2212 x 1659 pixels · FOV: 45 degrees:
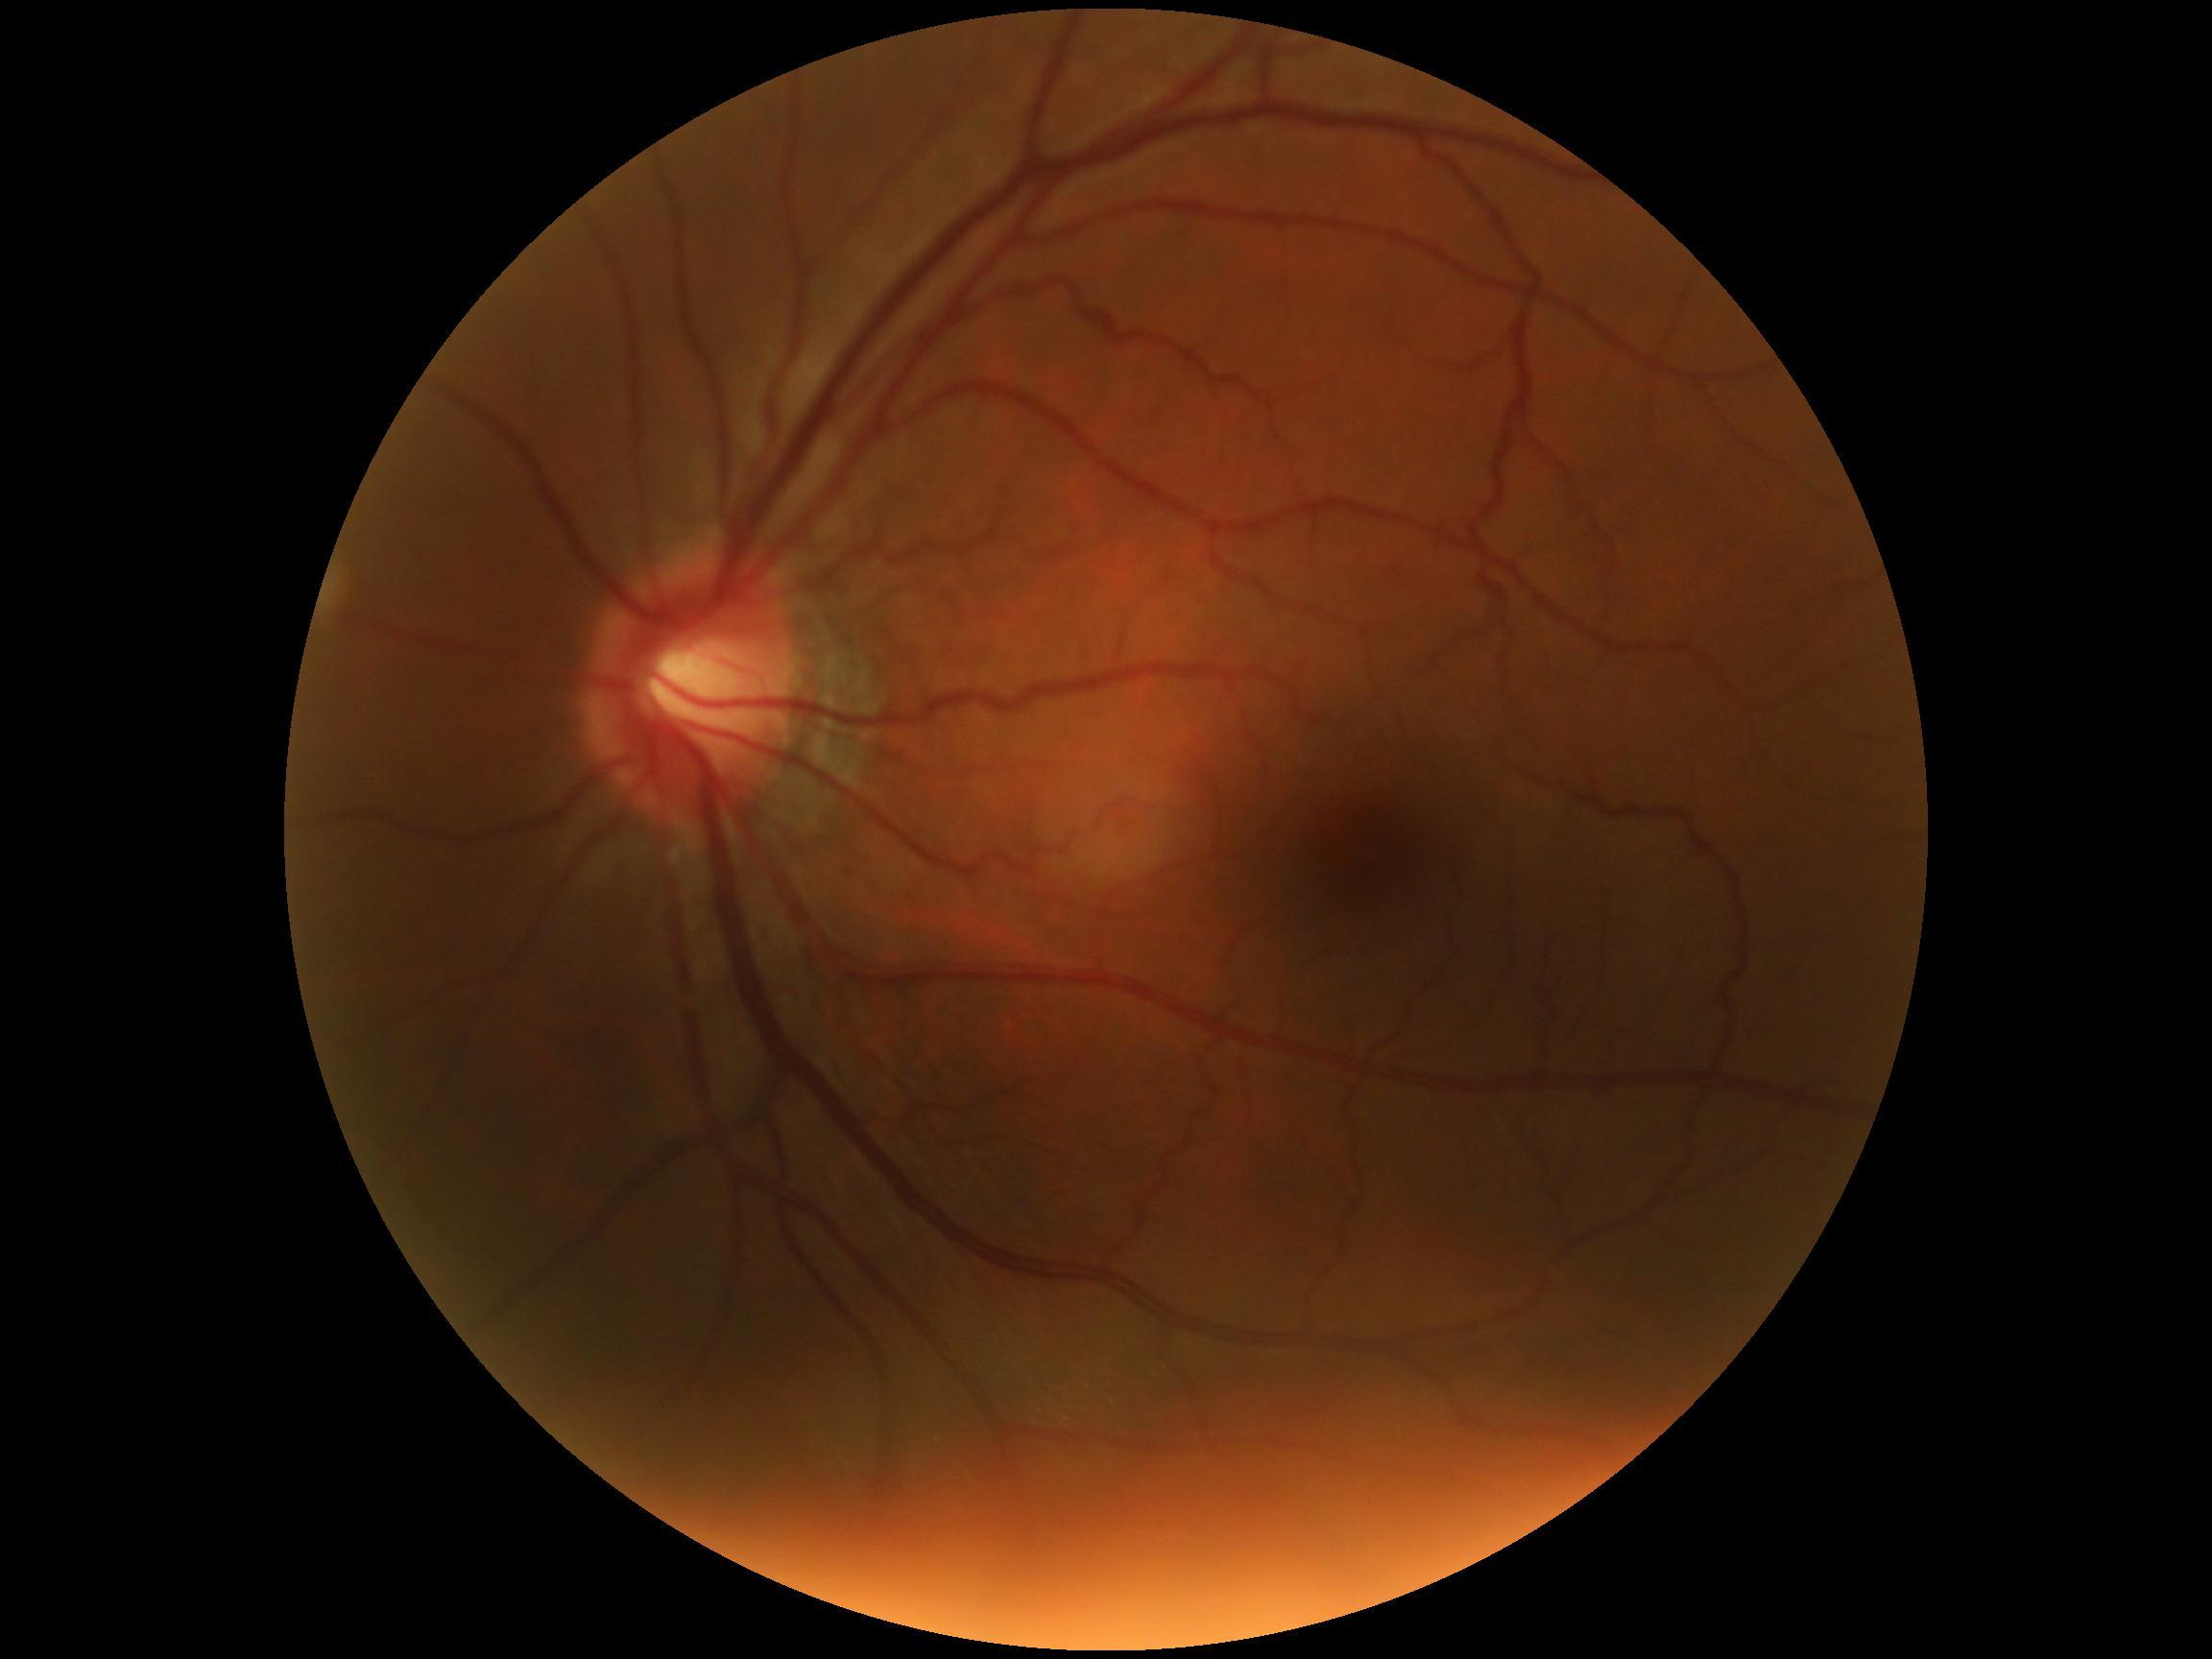
  dr_grade: grade 0 (no apparent retinopathy)